Retinal fundus photograph:
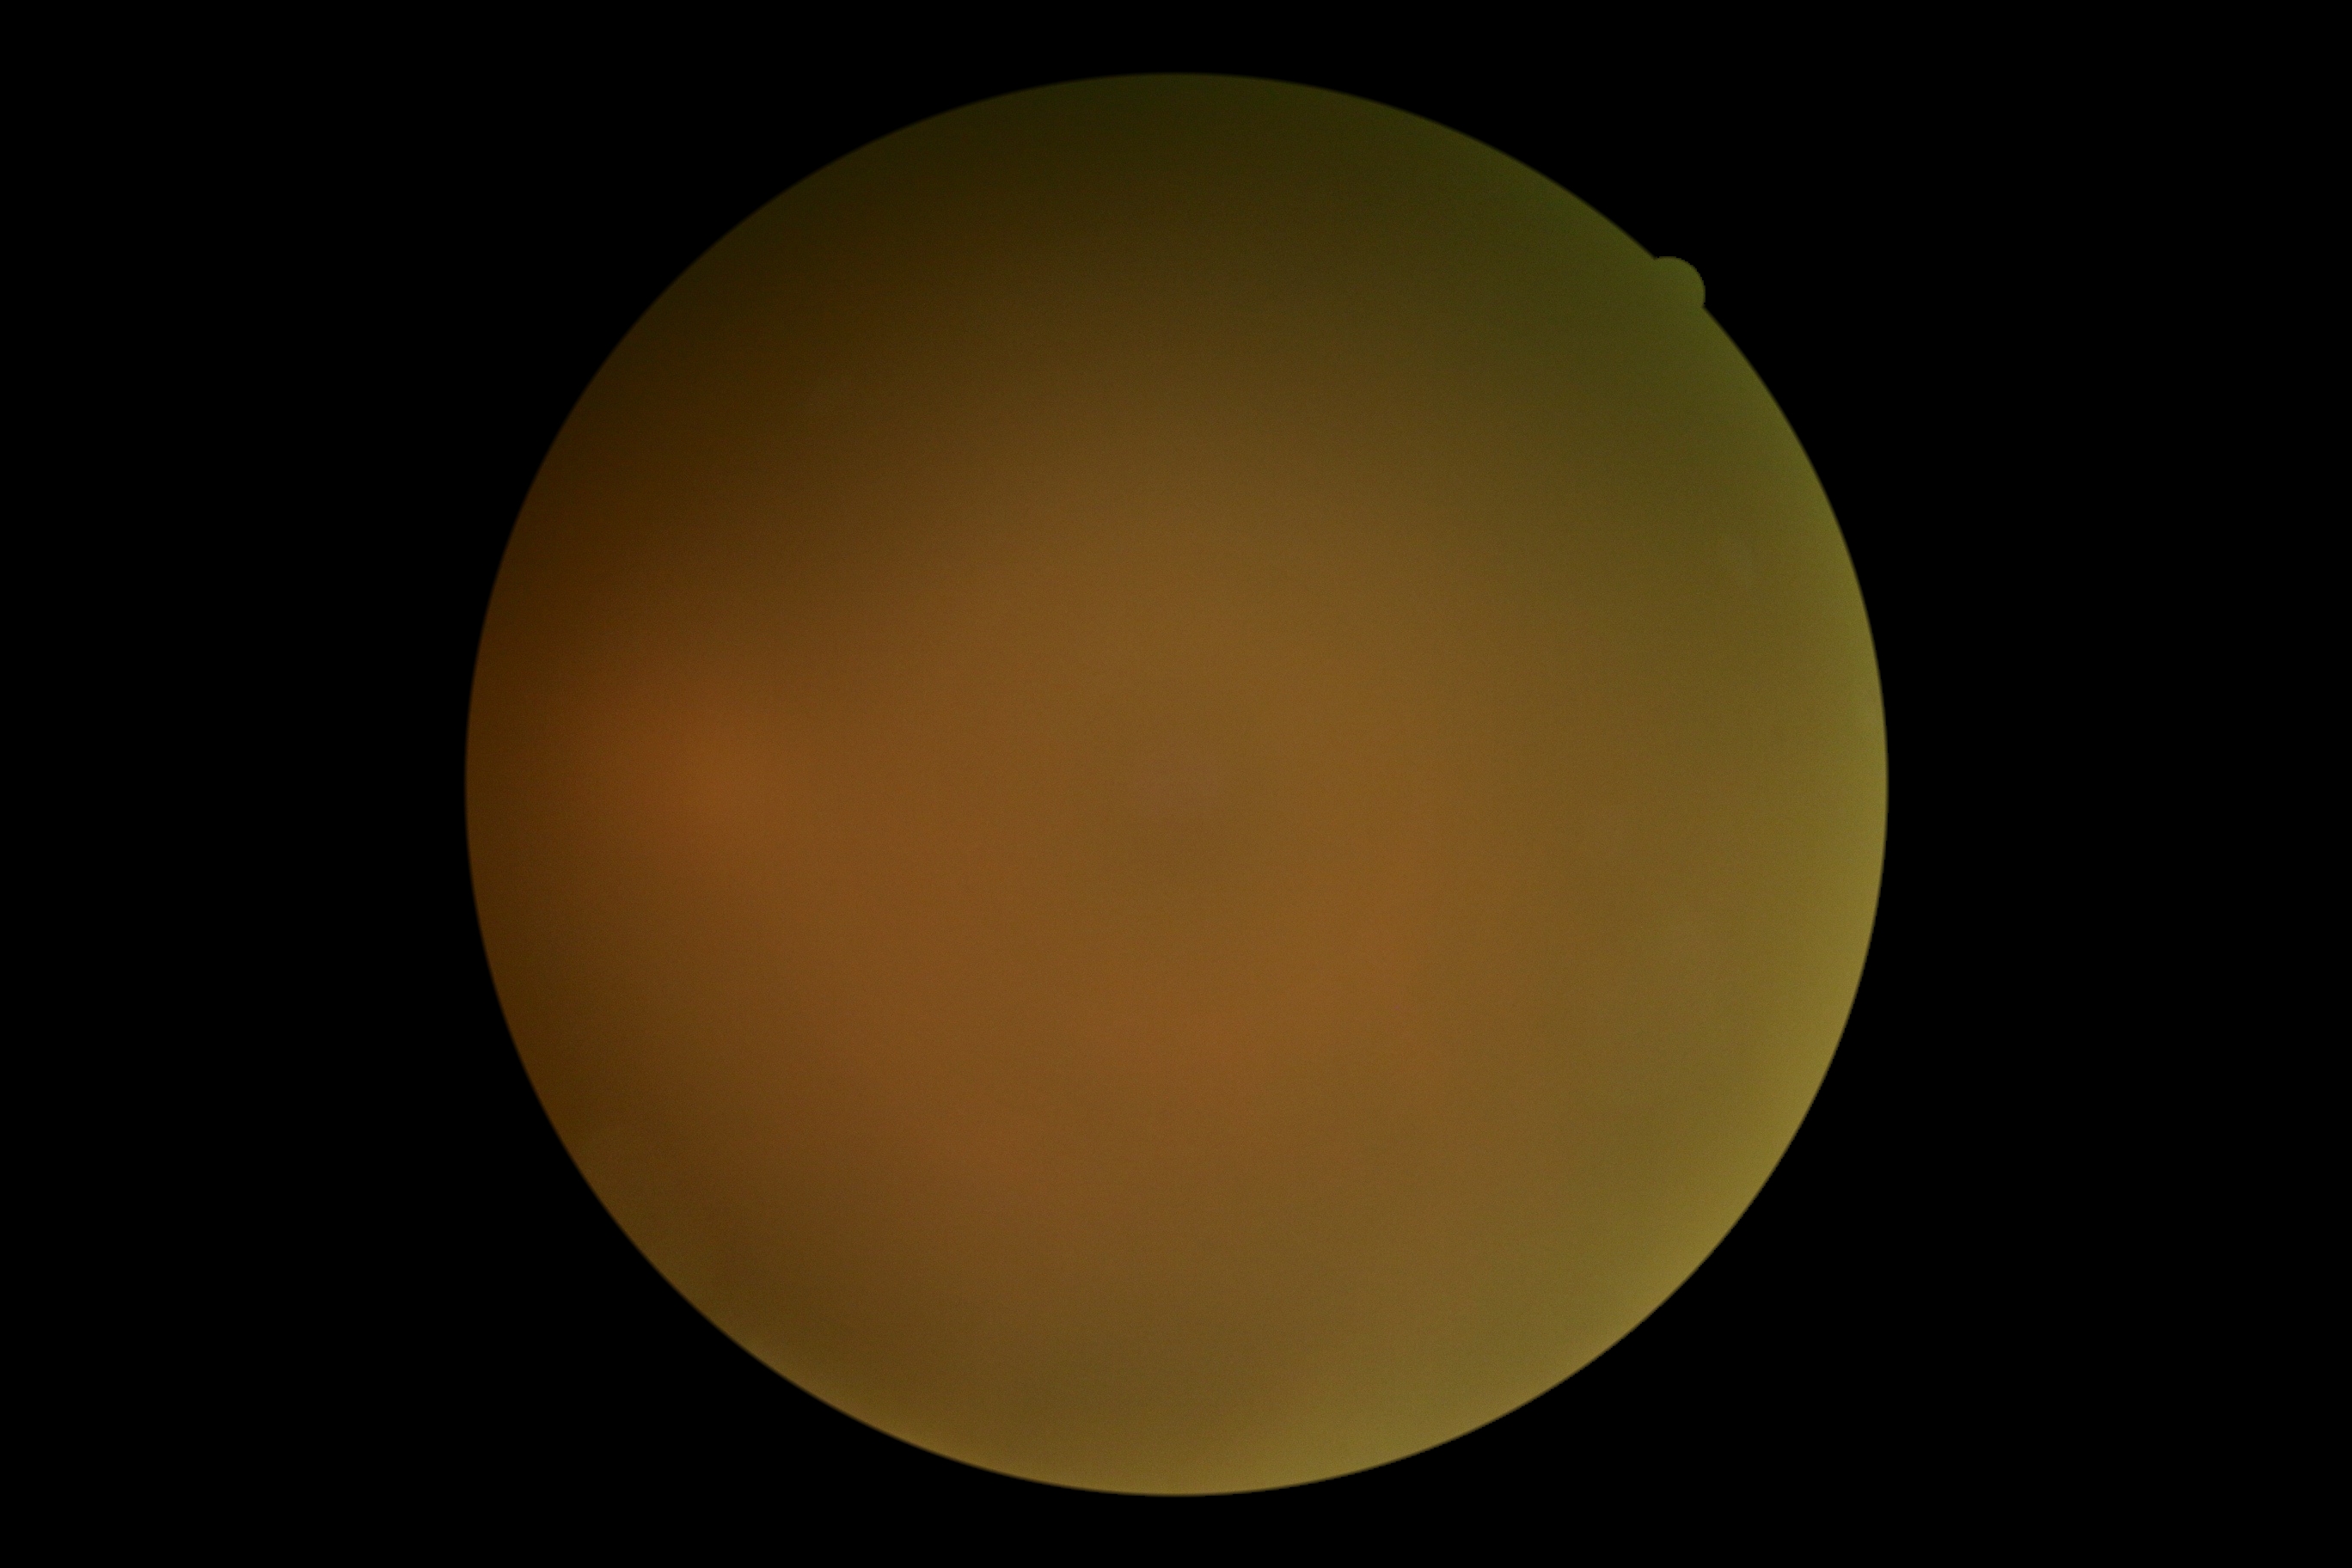 DR stage=ungradable due to poor image quality, image quality=too poor for DR grading.